Ultra-widefield fundus mosaic. 200-degree field of view.
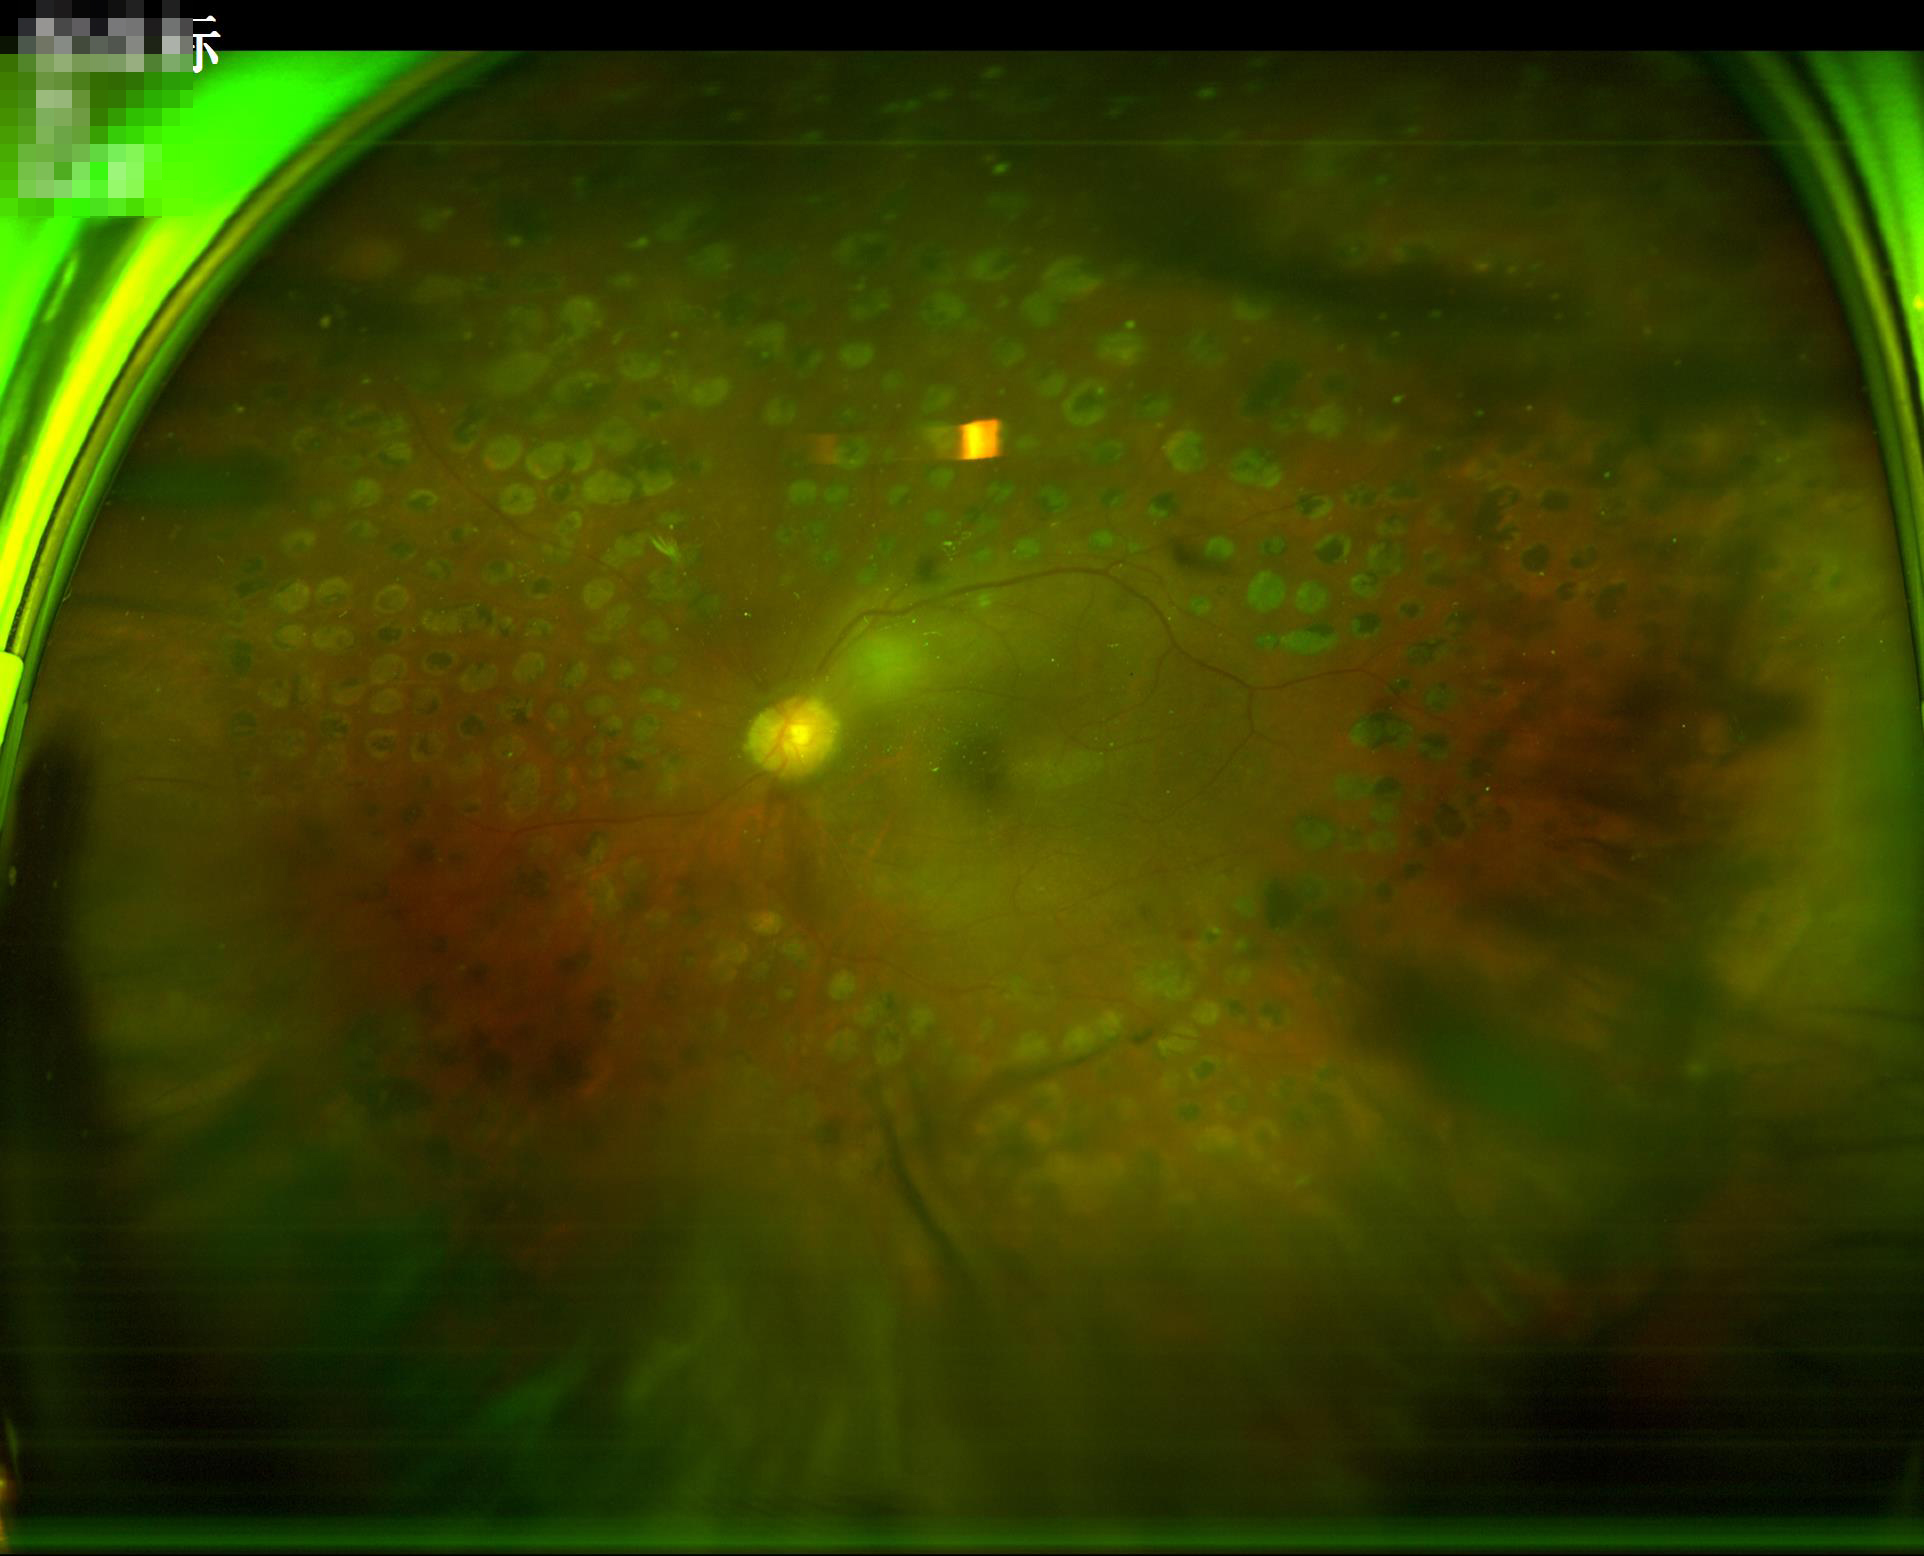
Noticeable blur in the optic disc, vessels, or background. Good dynamic range. Poor illumination with uneven exposure. Image quality is inadequate for diagnostic use.